Nidek AFC-330 · 240x240px · centered on the optic disc
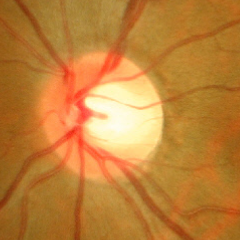 Impression = no glaucomatous optic neuropathy.